Phoenix ICON wide-field infant fundus image. 1240x1240px. Acquired on the Phoenix ICON: 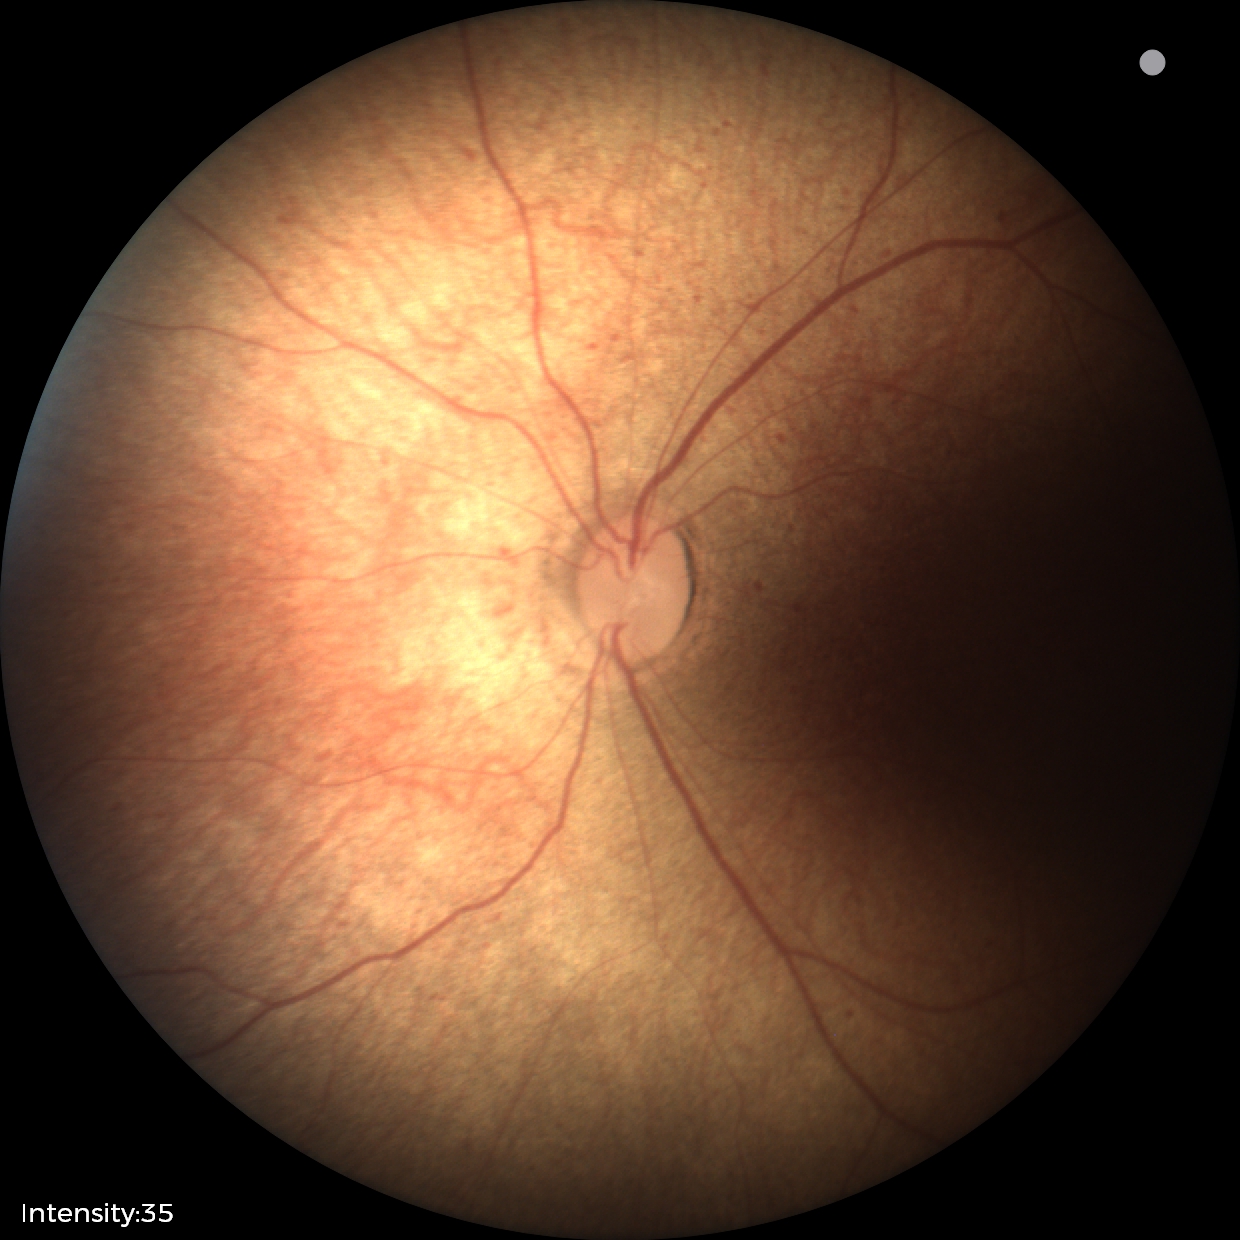 Examination with physiological retinal findings.